Diabetic retinopathy graded by the modified Davis classification:
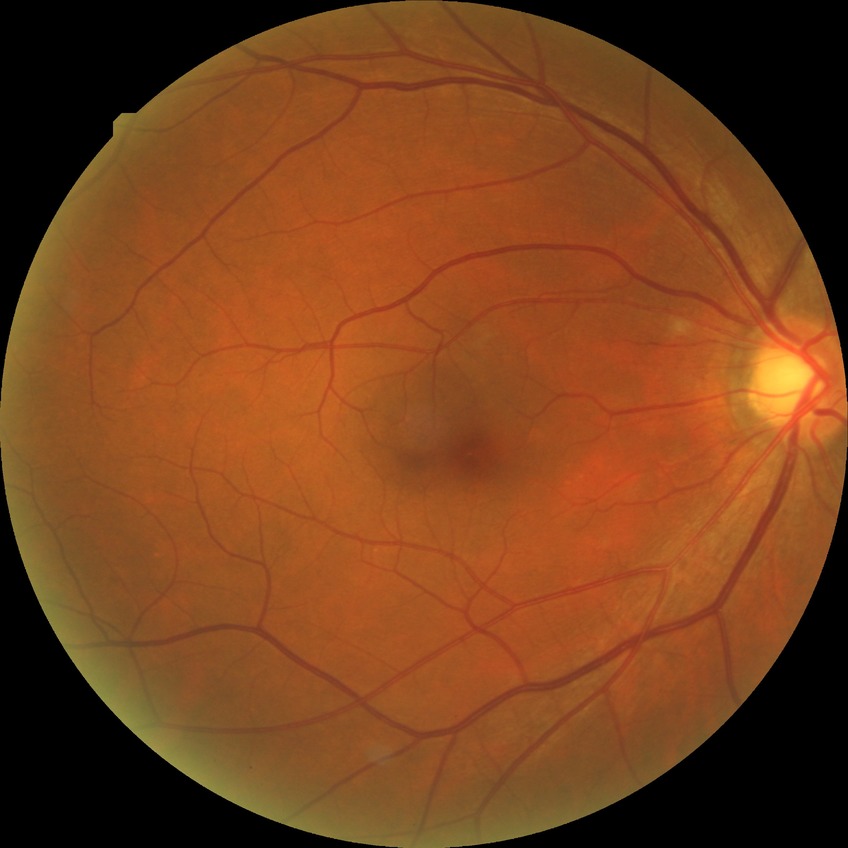
{"davis_grade": "simple diabetic retinopathy (SDR)"}